Wide-field fundus photograph from neonatal ROP screening · camera: Clarity RetCam 3 (130° FOV): 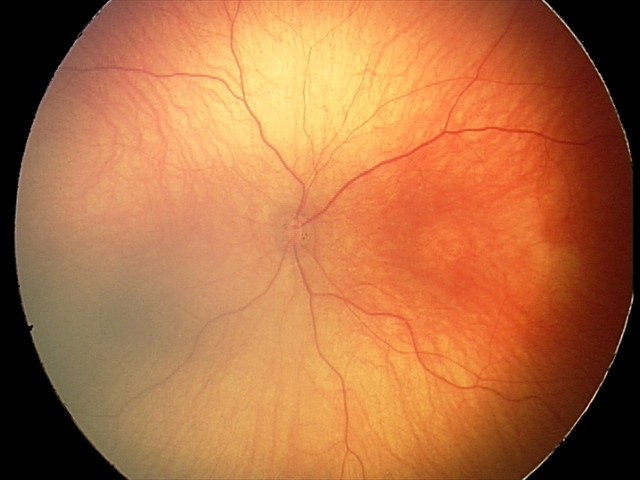 Screening examination consistent with optic nerve hypoplasia.